Pediatric wide-field fundus photograph: 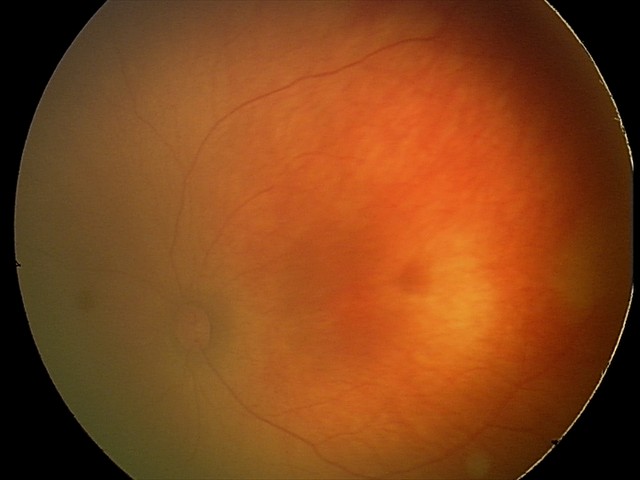 Screening examination diagnosed as physiological.